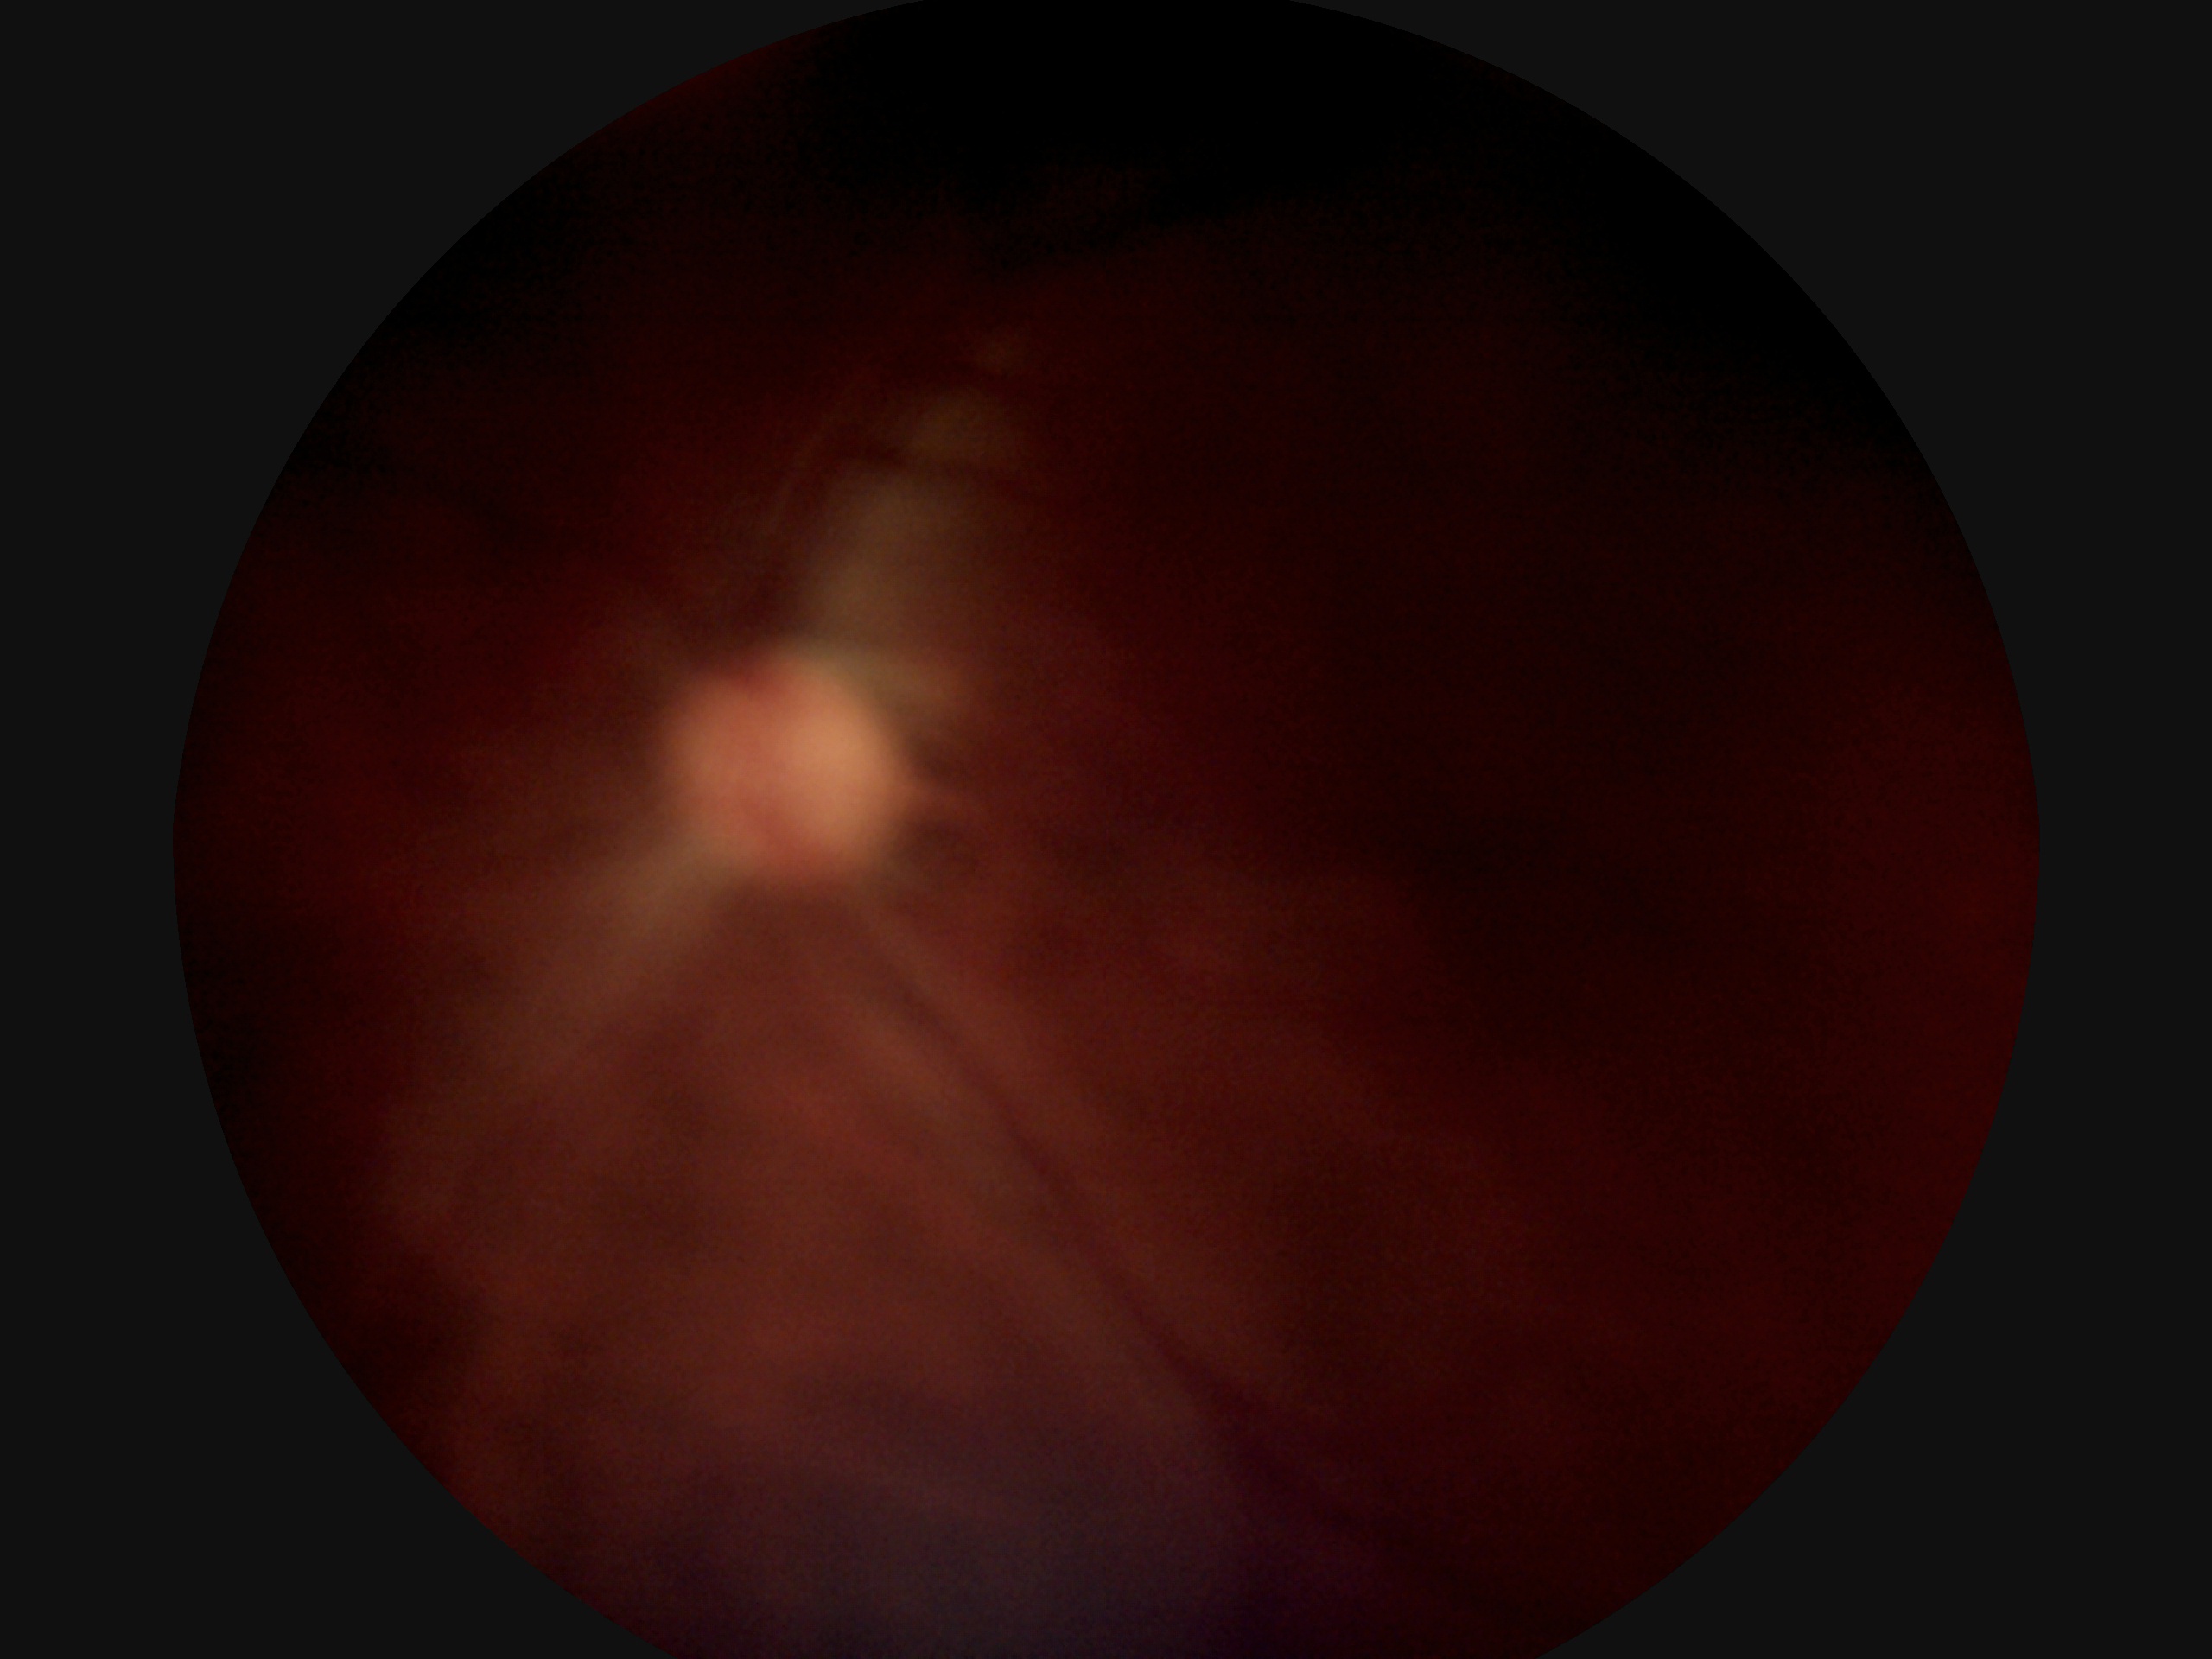

Diabetic retinopathy is ungradable. Image quality is insufficient for diabetic retinopathy assessment.